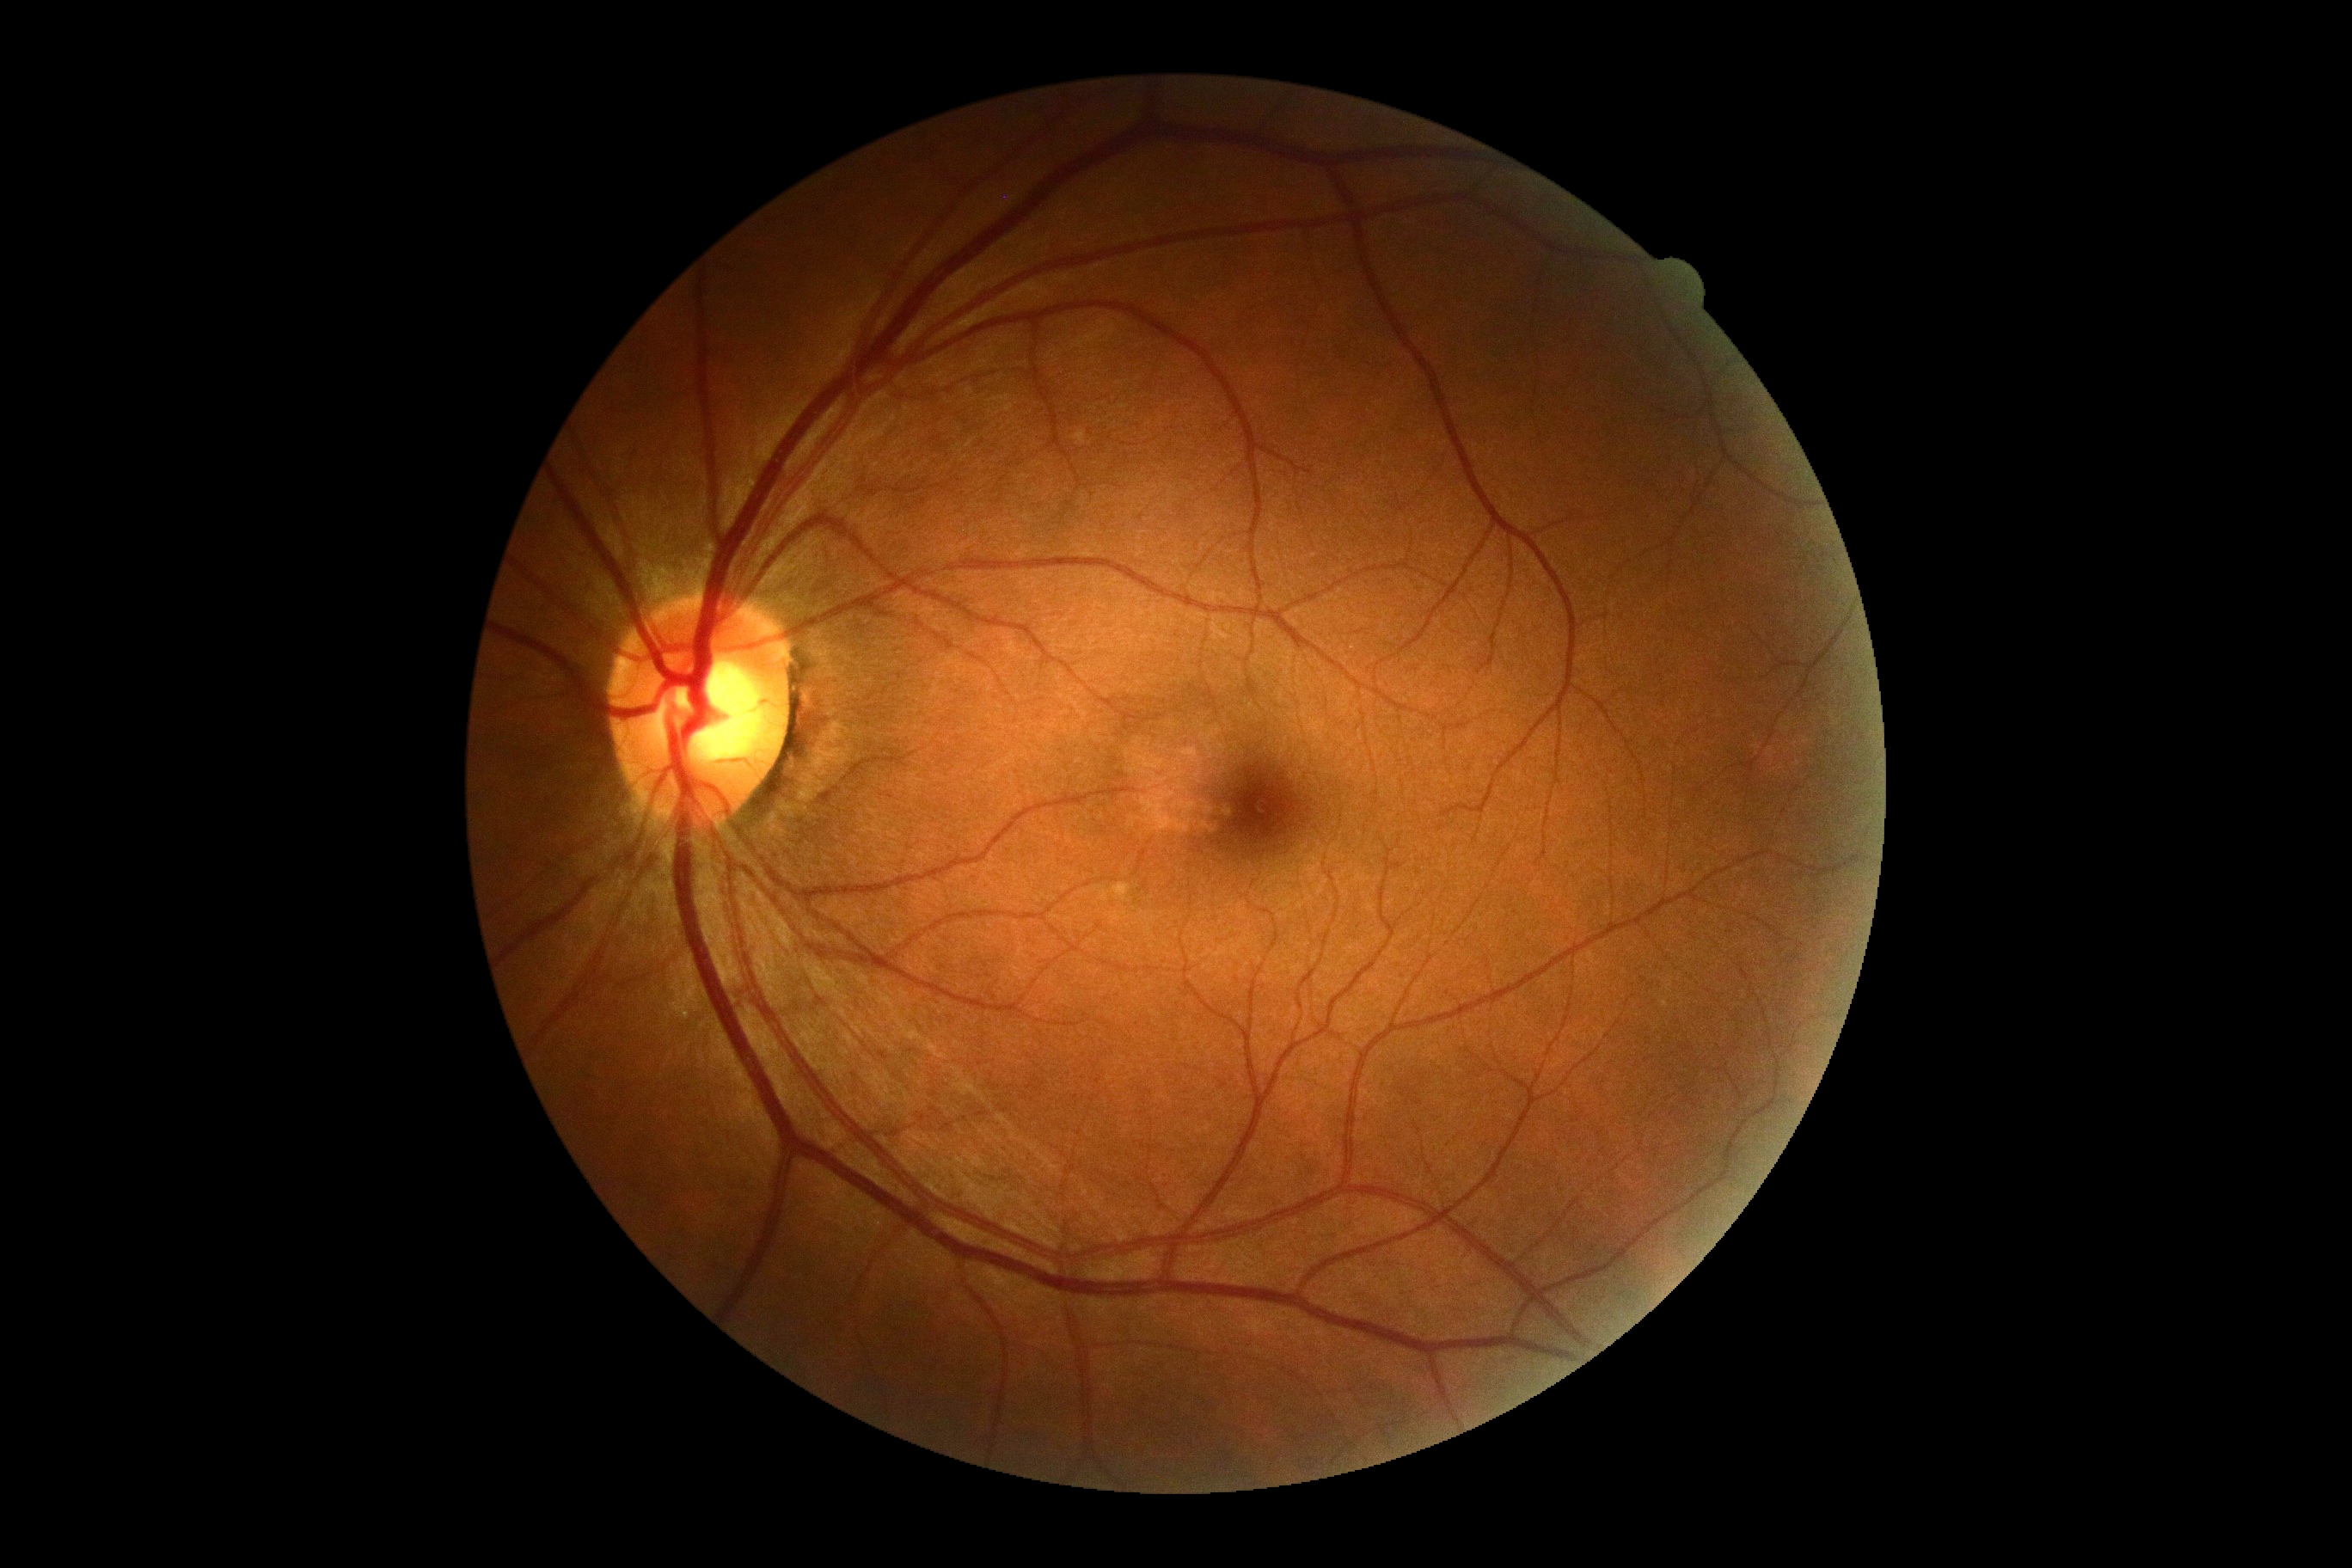 Diabetic retinopathy grade: 0 (no apparent retinopathy) — no visible signs of diabetic retinopathy.